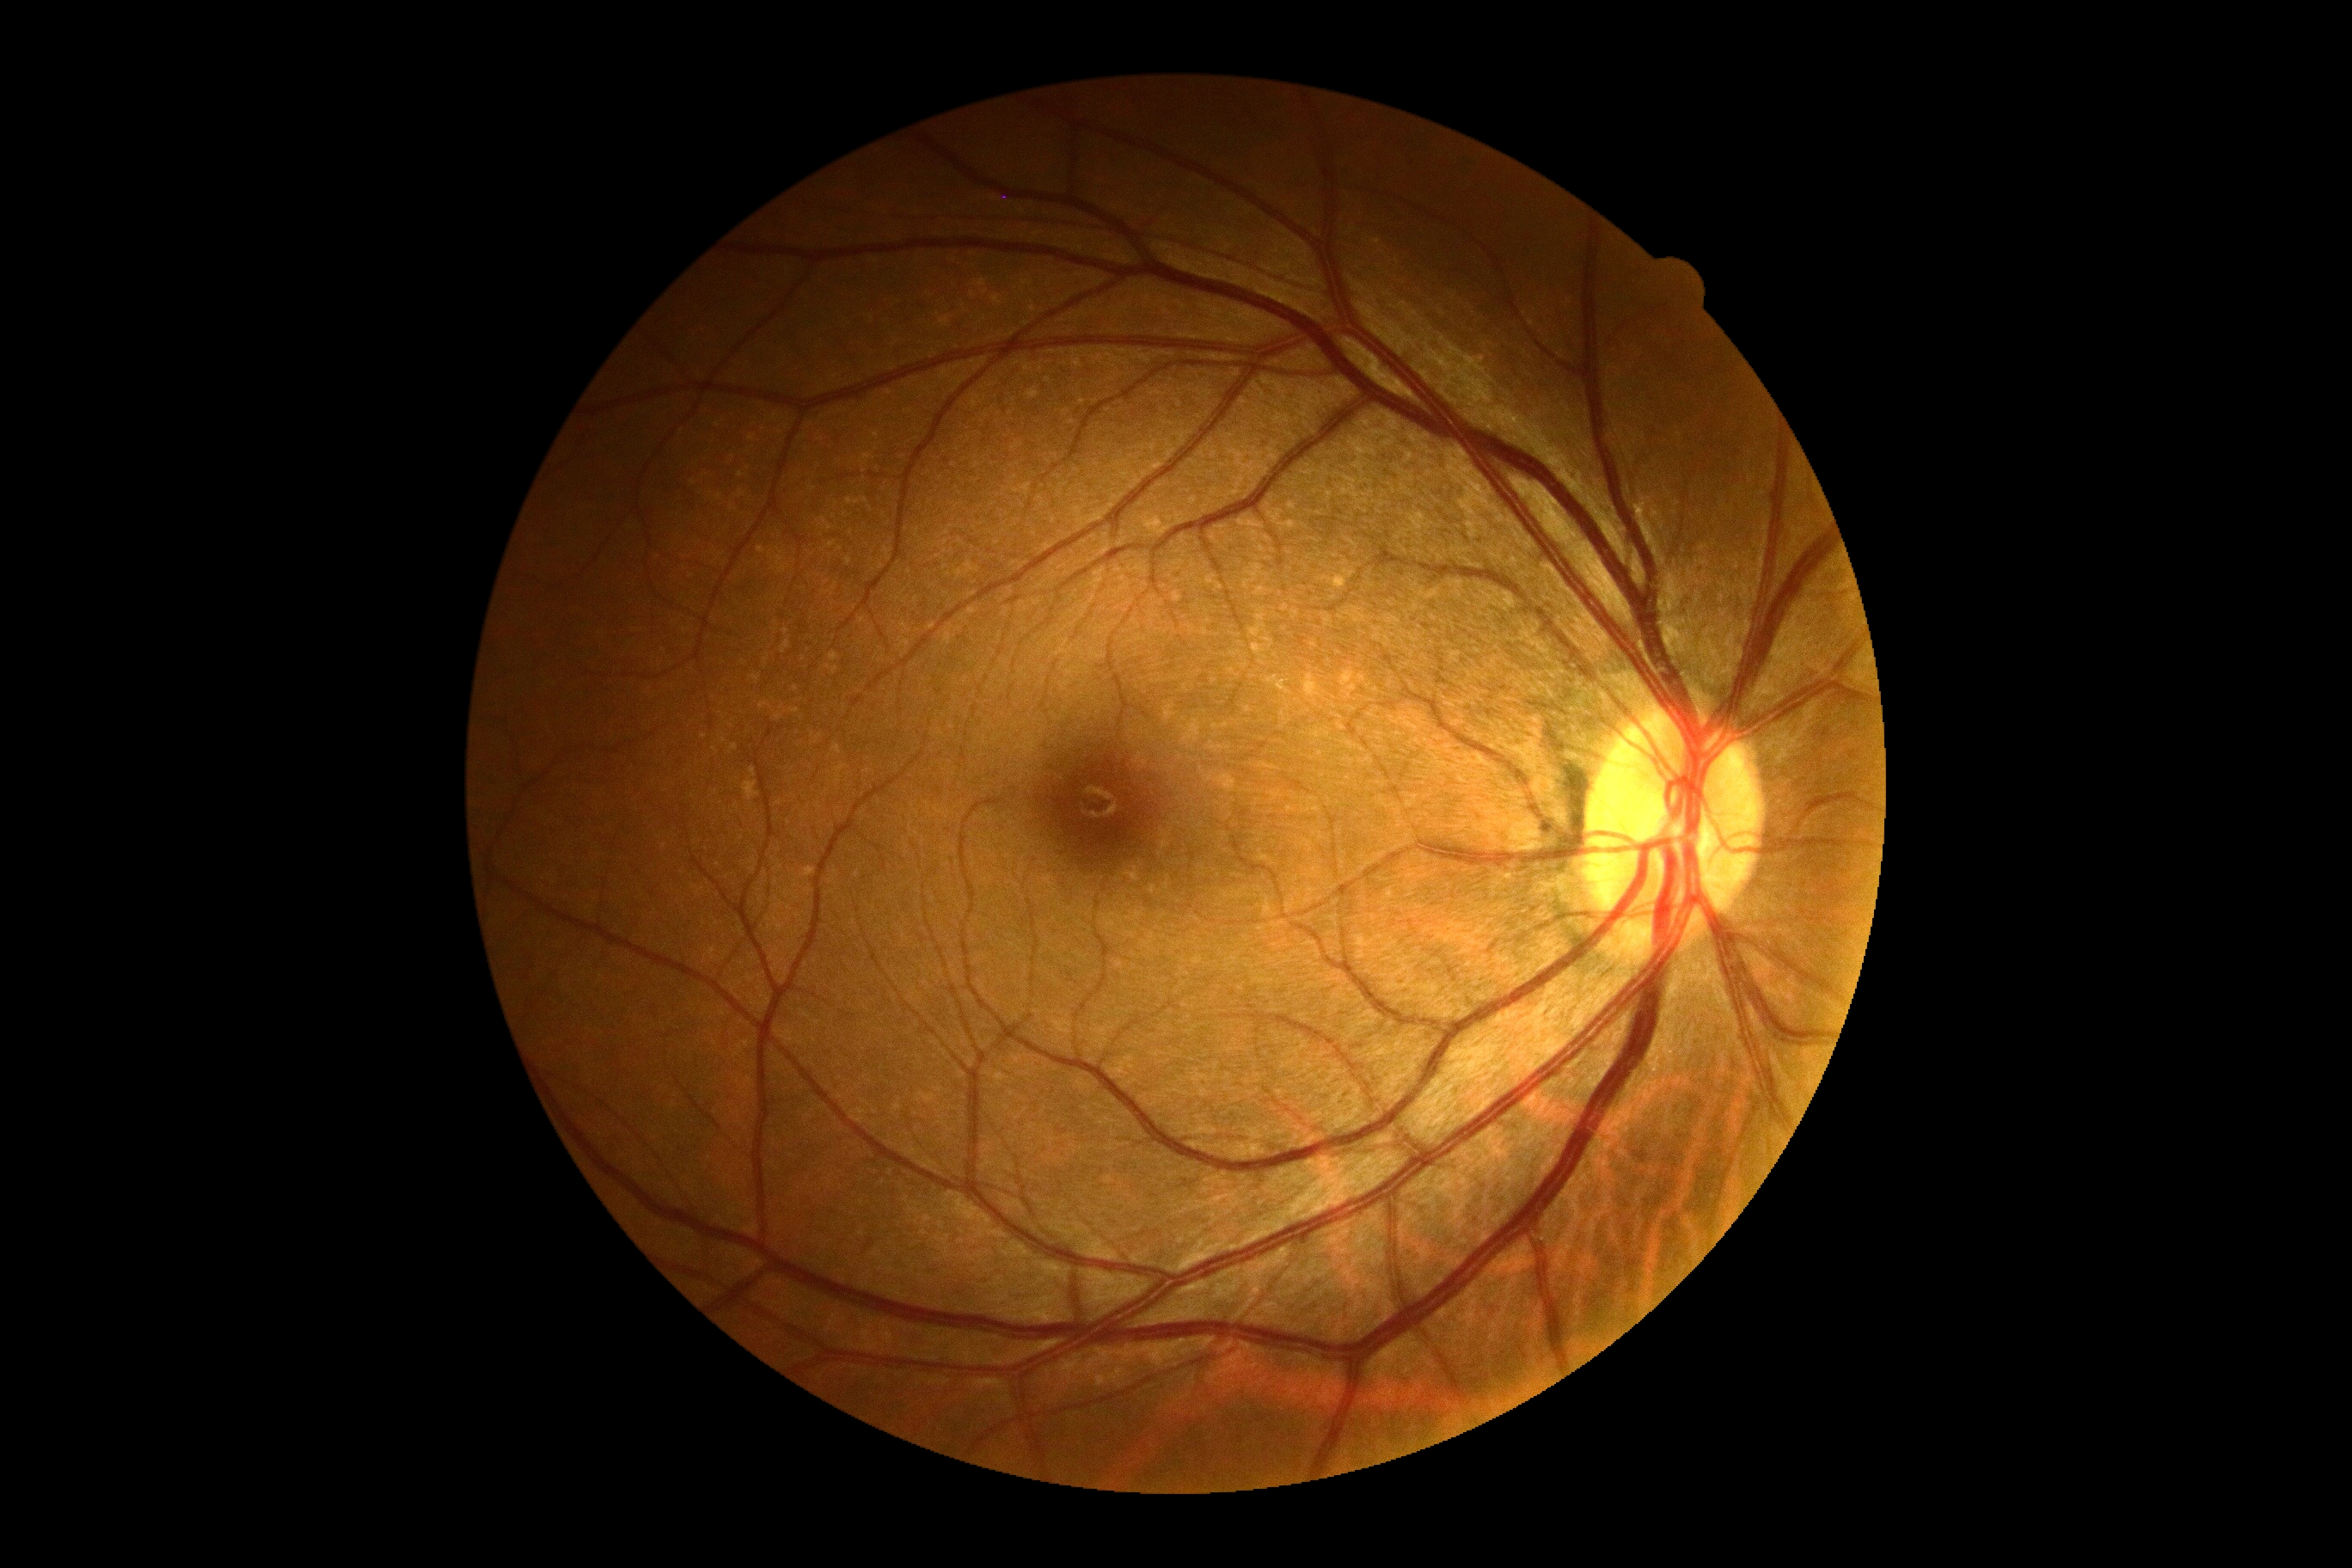
Diabetic retinopathy is grade 0 (no apparent retinopathy).